1920 x 1440 pixels
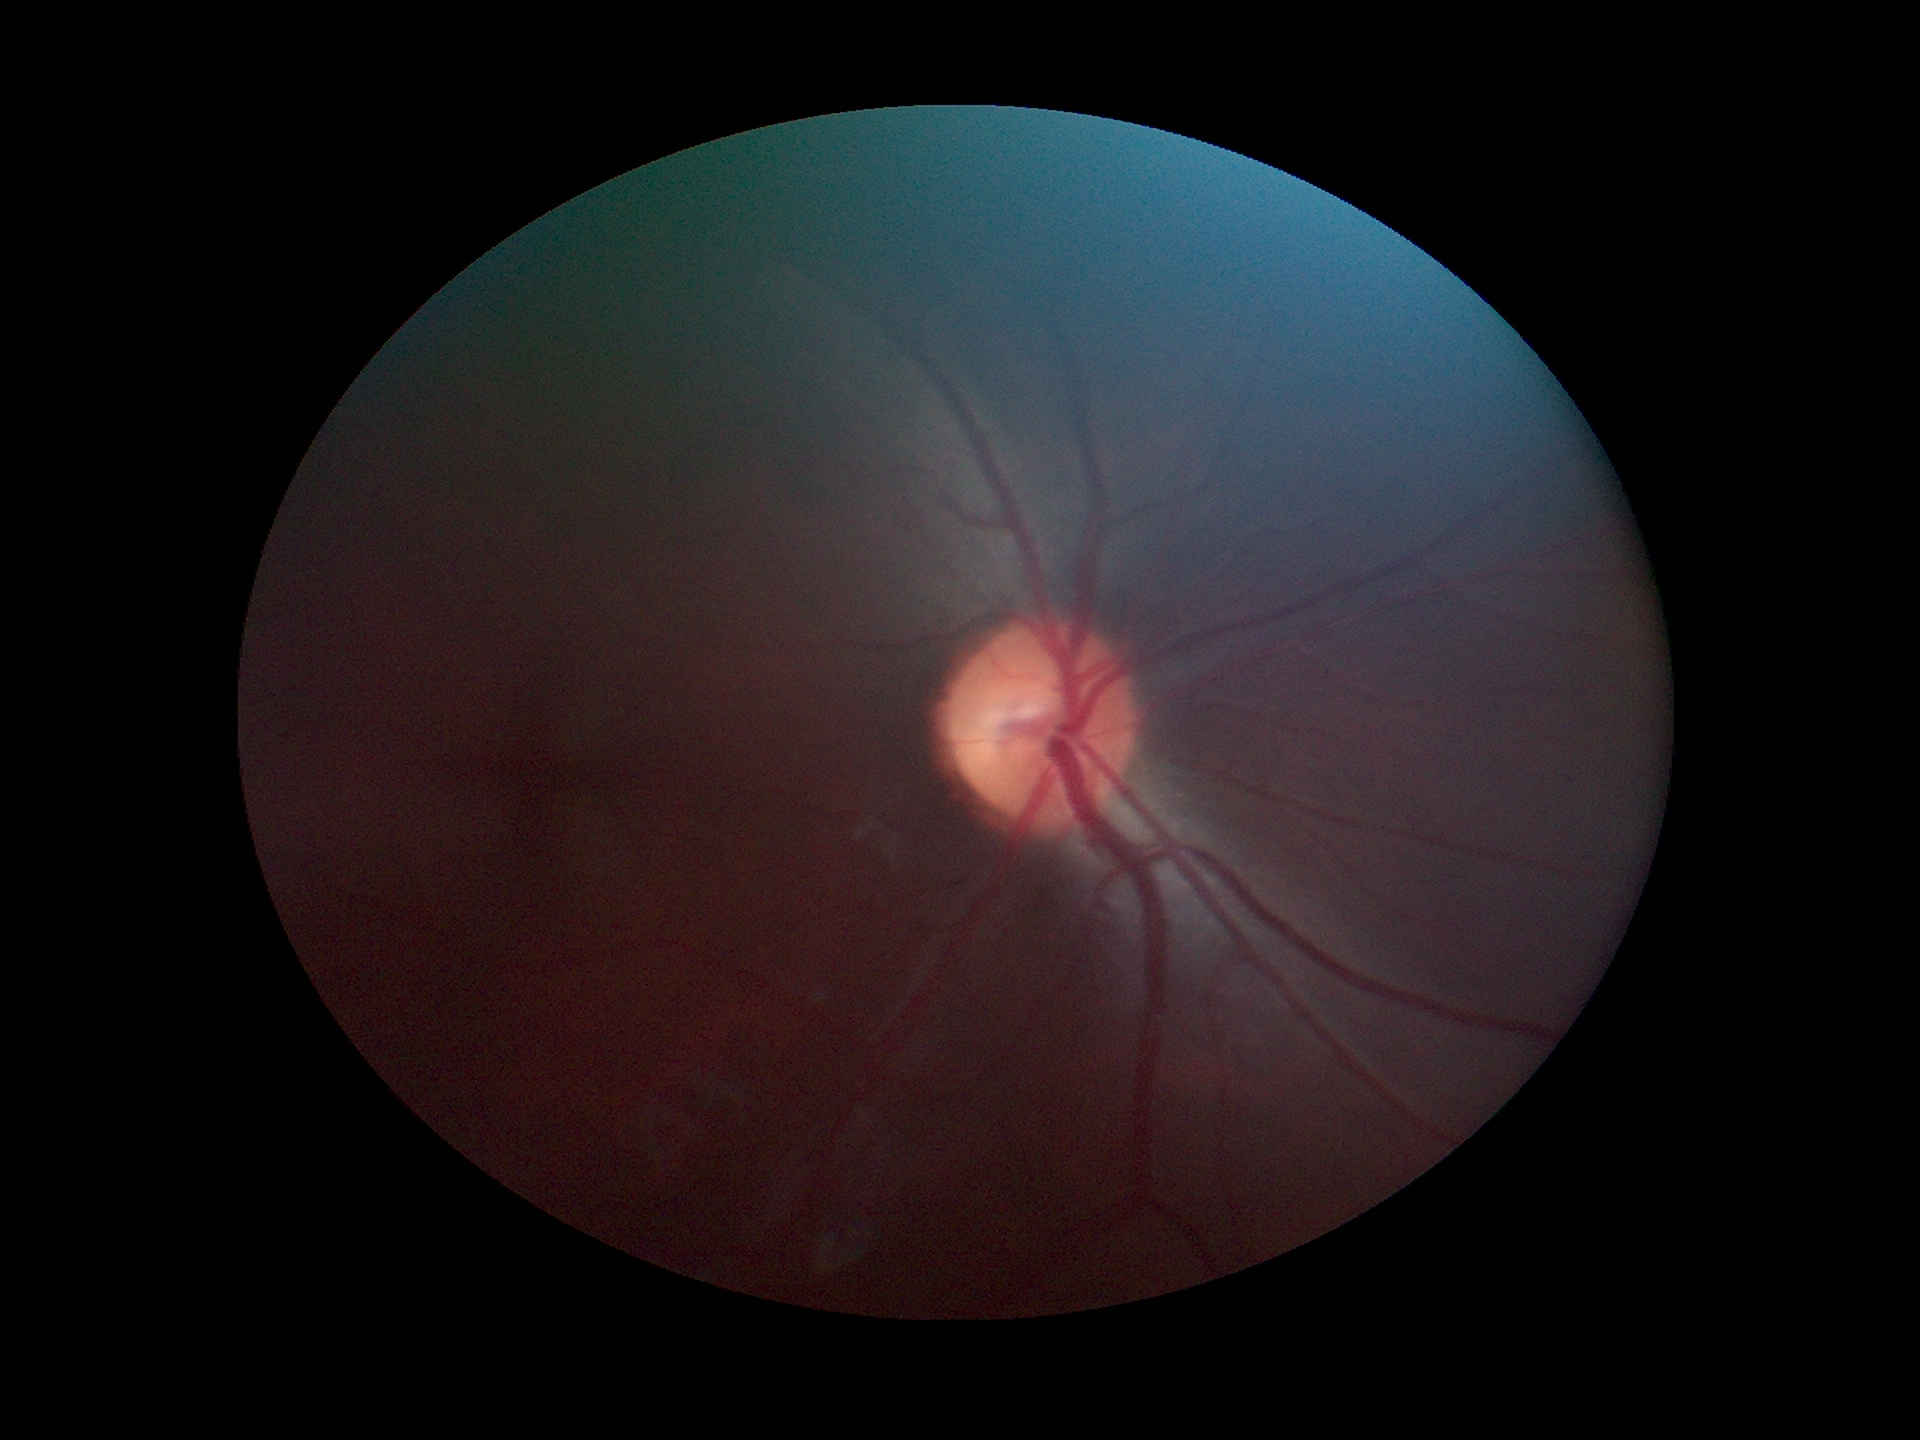
Glaucoma assessment: no suspicious findings.
Horizontal cup-to-disc ratio: 0.54.
Vertical C/D ratio: 0.49.